Fundus photo:
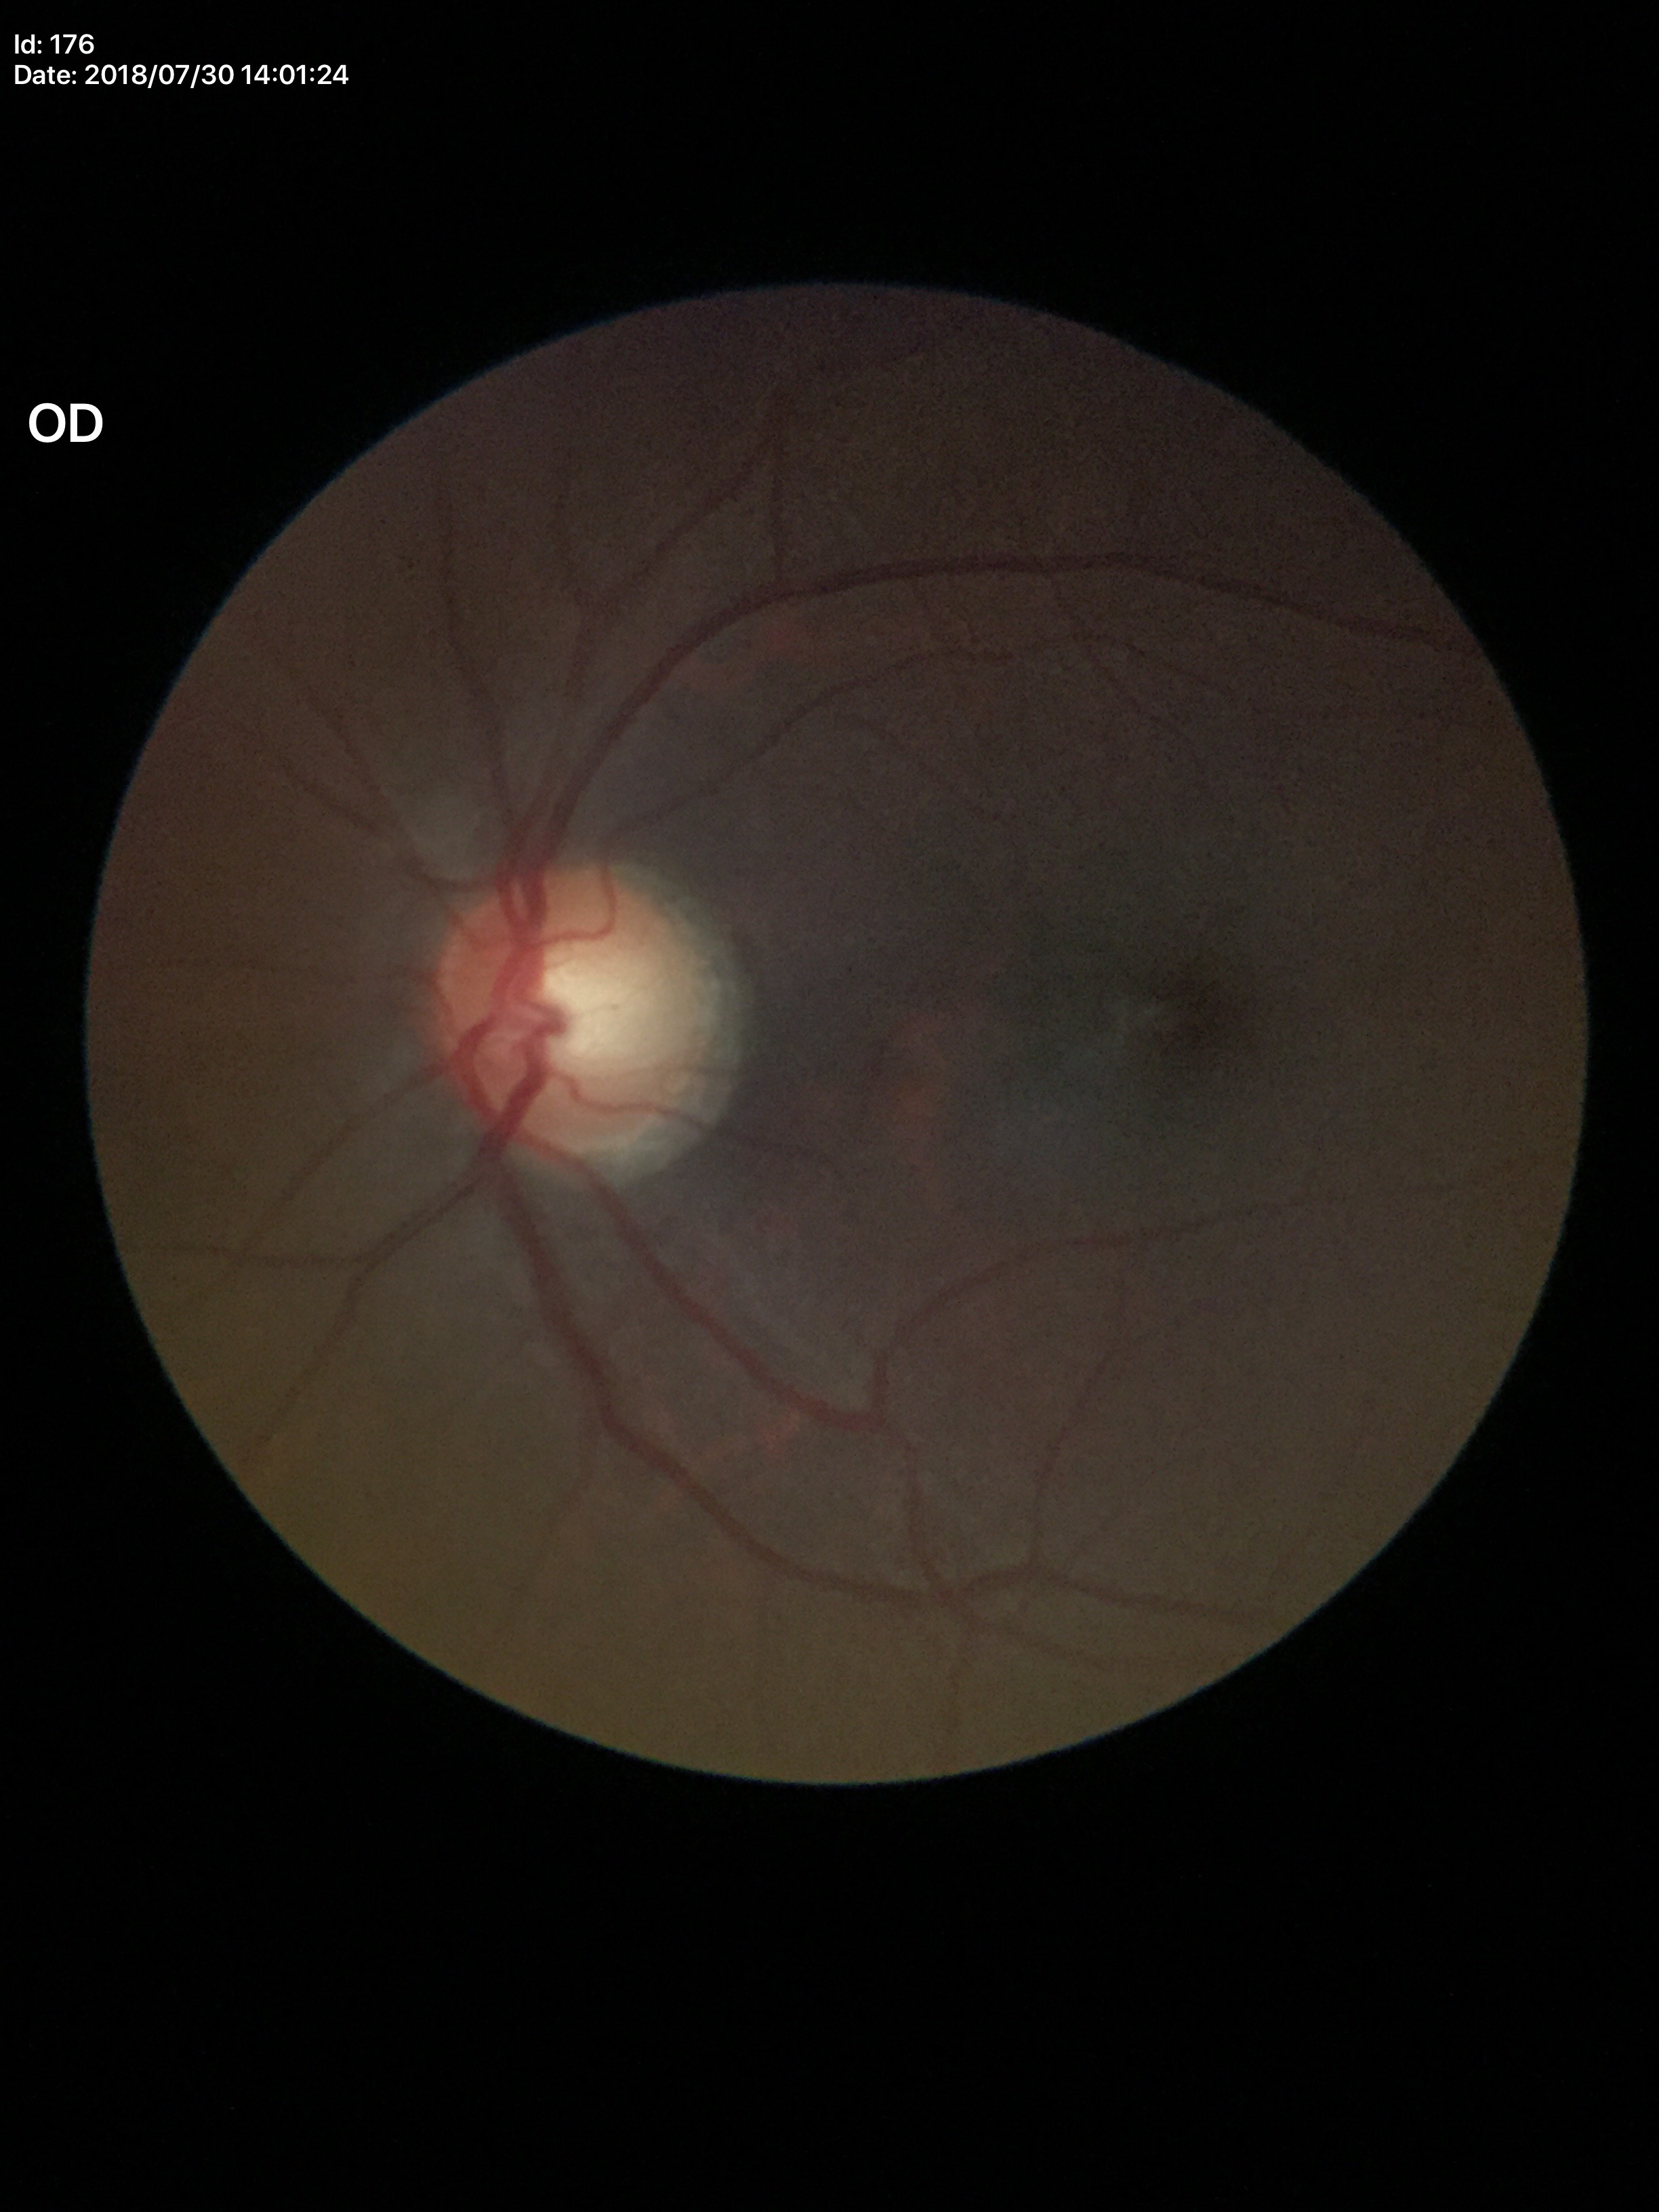 Vertical CDR: 0.60.
Area cup-to-disc ratio: 0.34.
Glaucoma screening impression: no suspicious findings.
Horizontal cup-disc ratio: 0.58.